848 x 848 pixels. Nonmydriatic fundus photograph. 45° FOV.
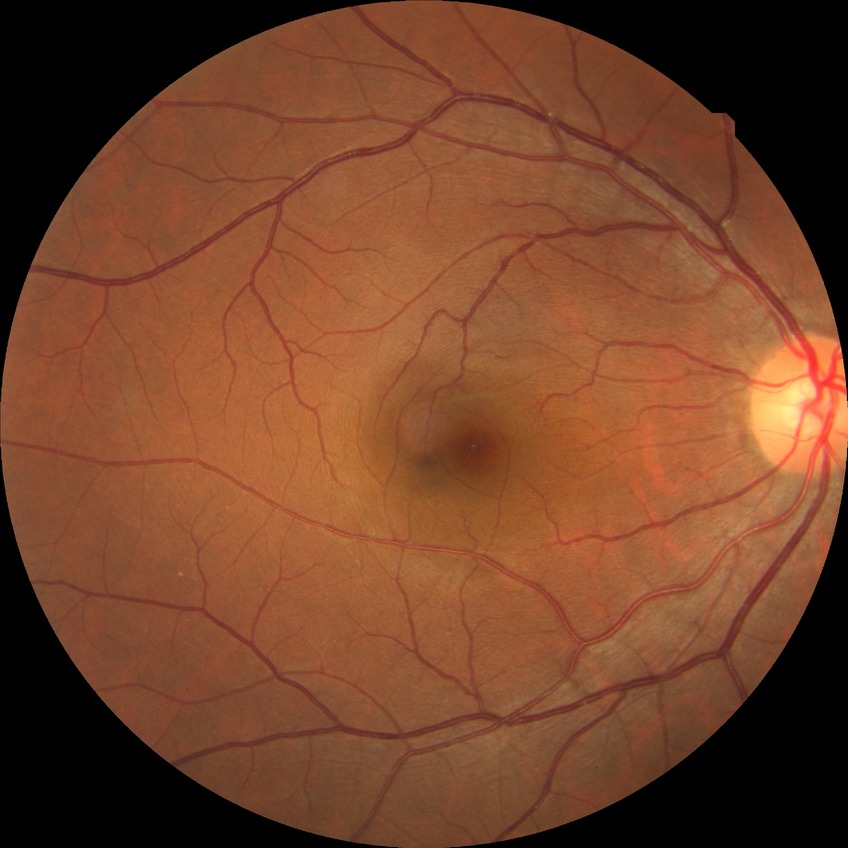 Davis DR grade is NDR.